Retinal fundus photograph; image size 2212x1659; 45° field of view: 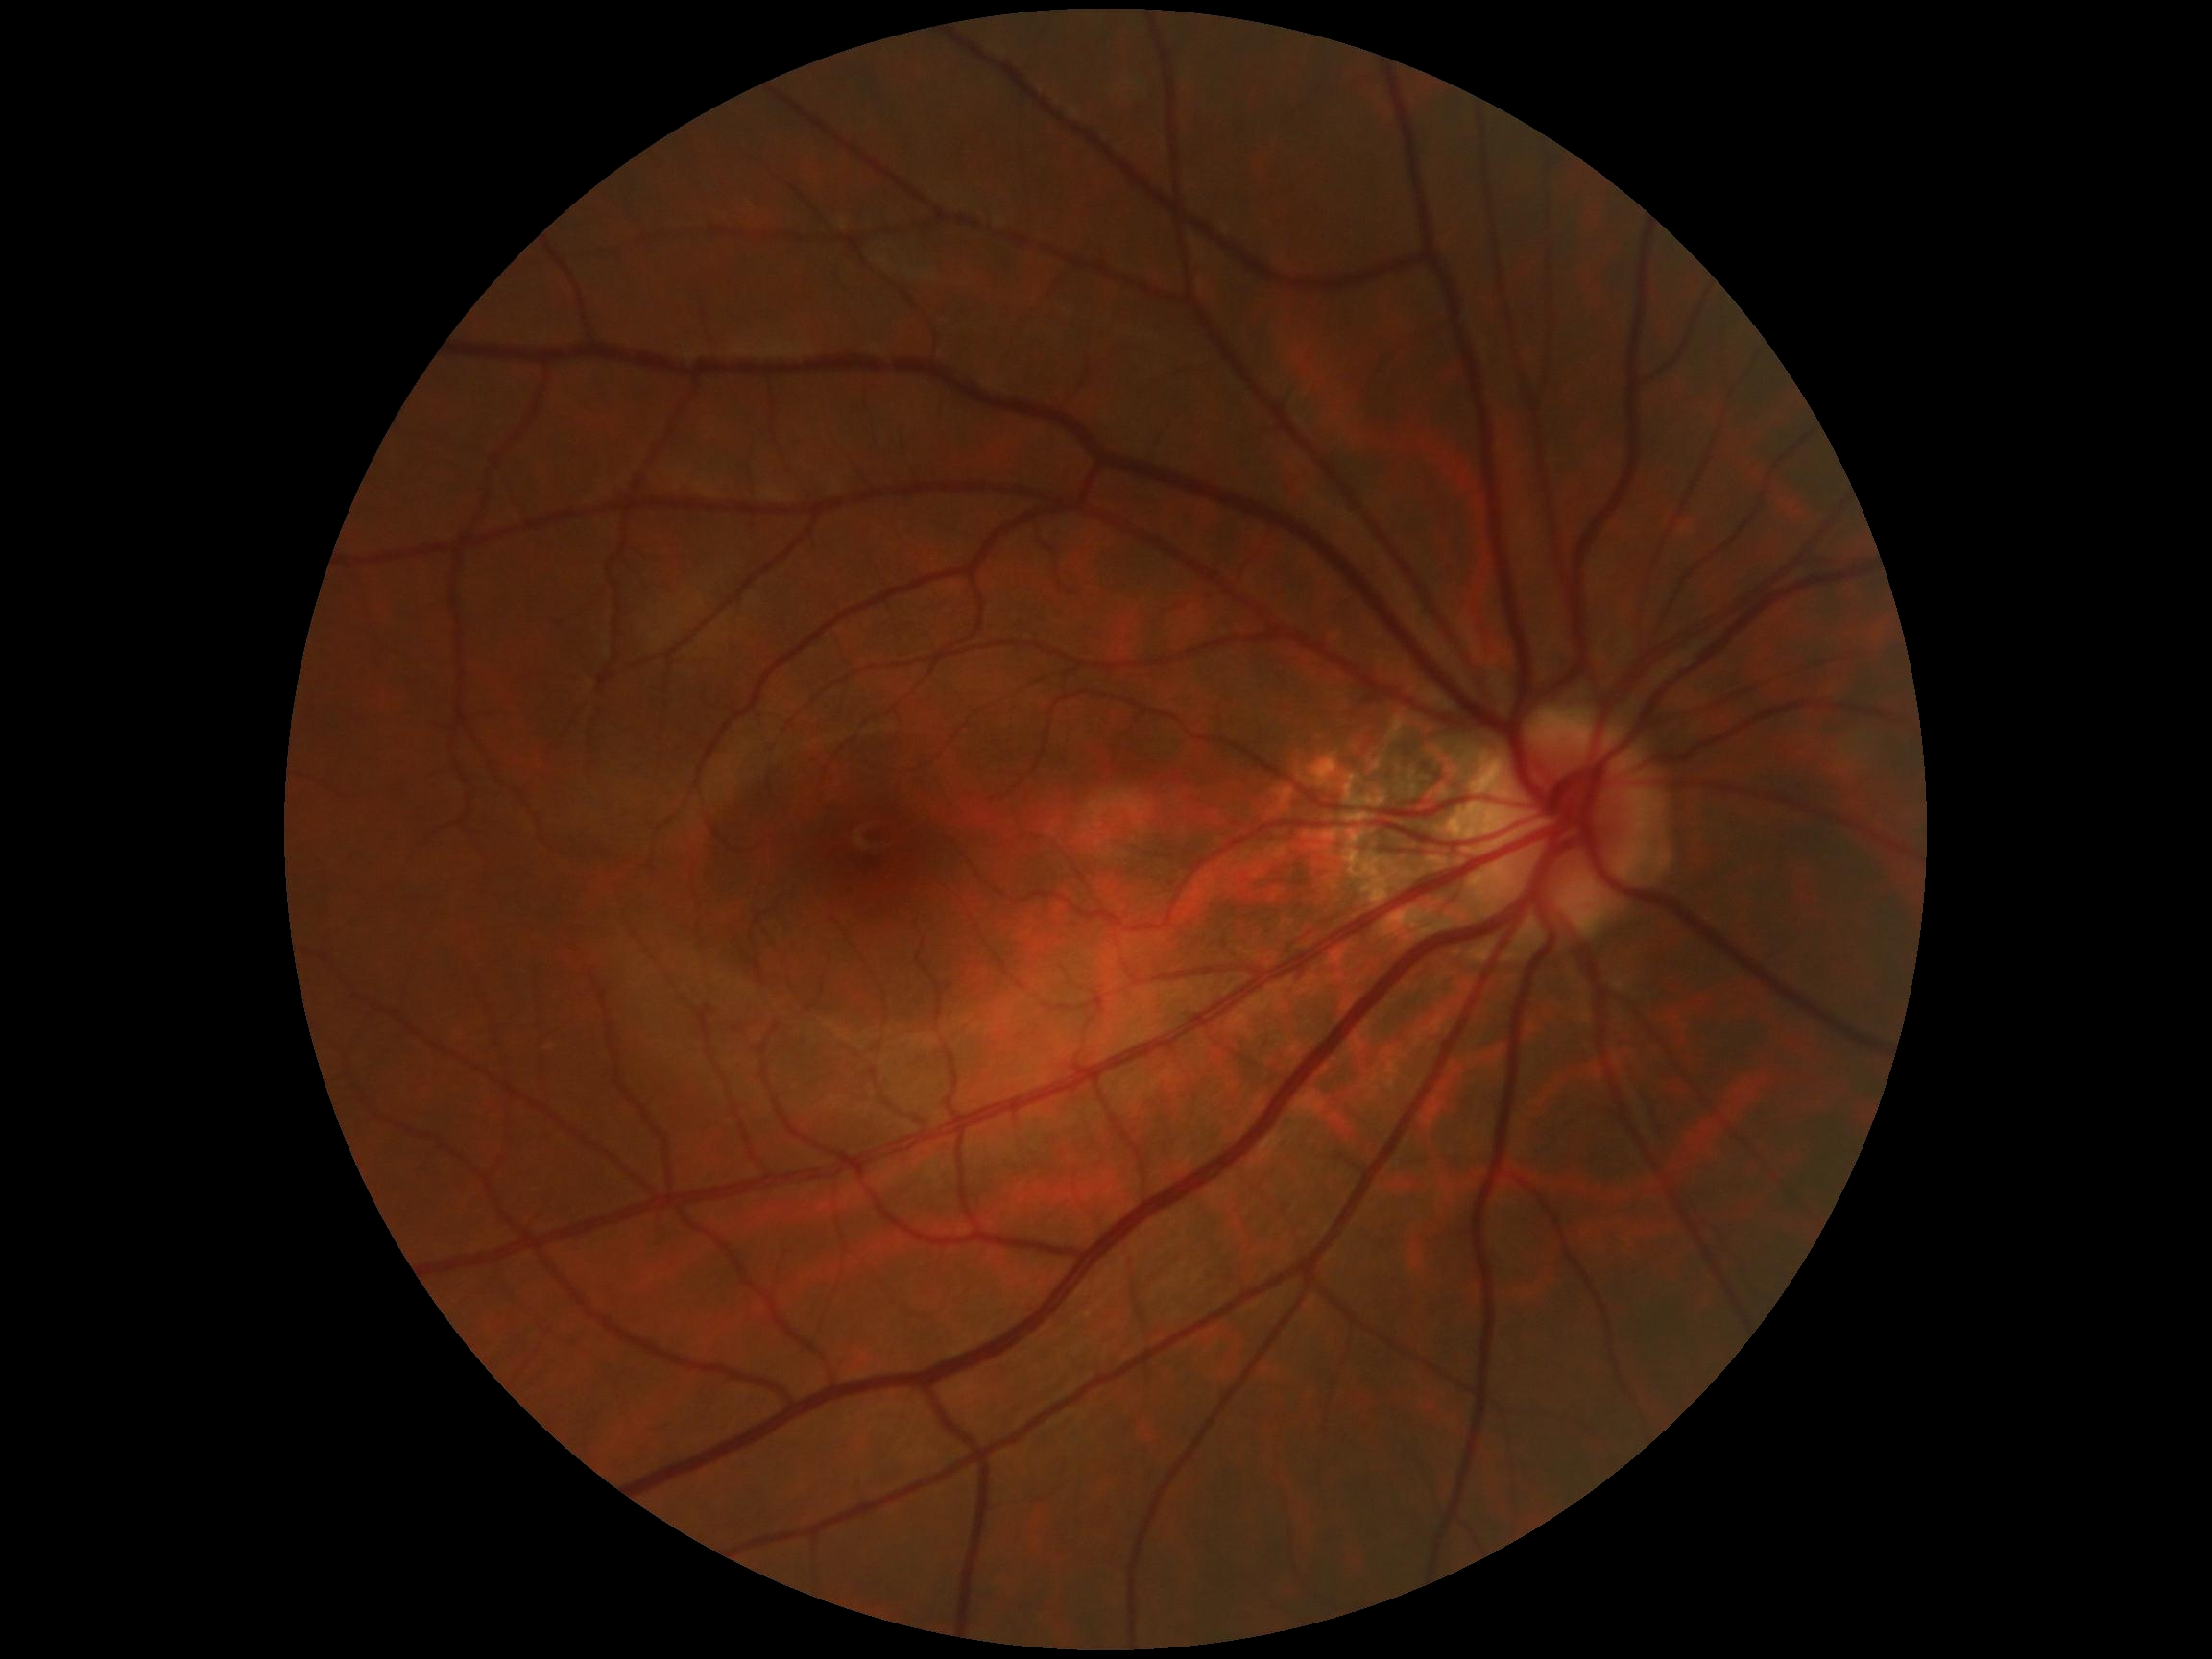

retinopathy: grade 0 (no apparent retinopathy).